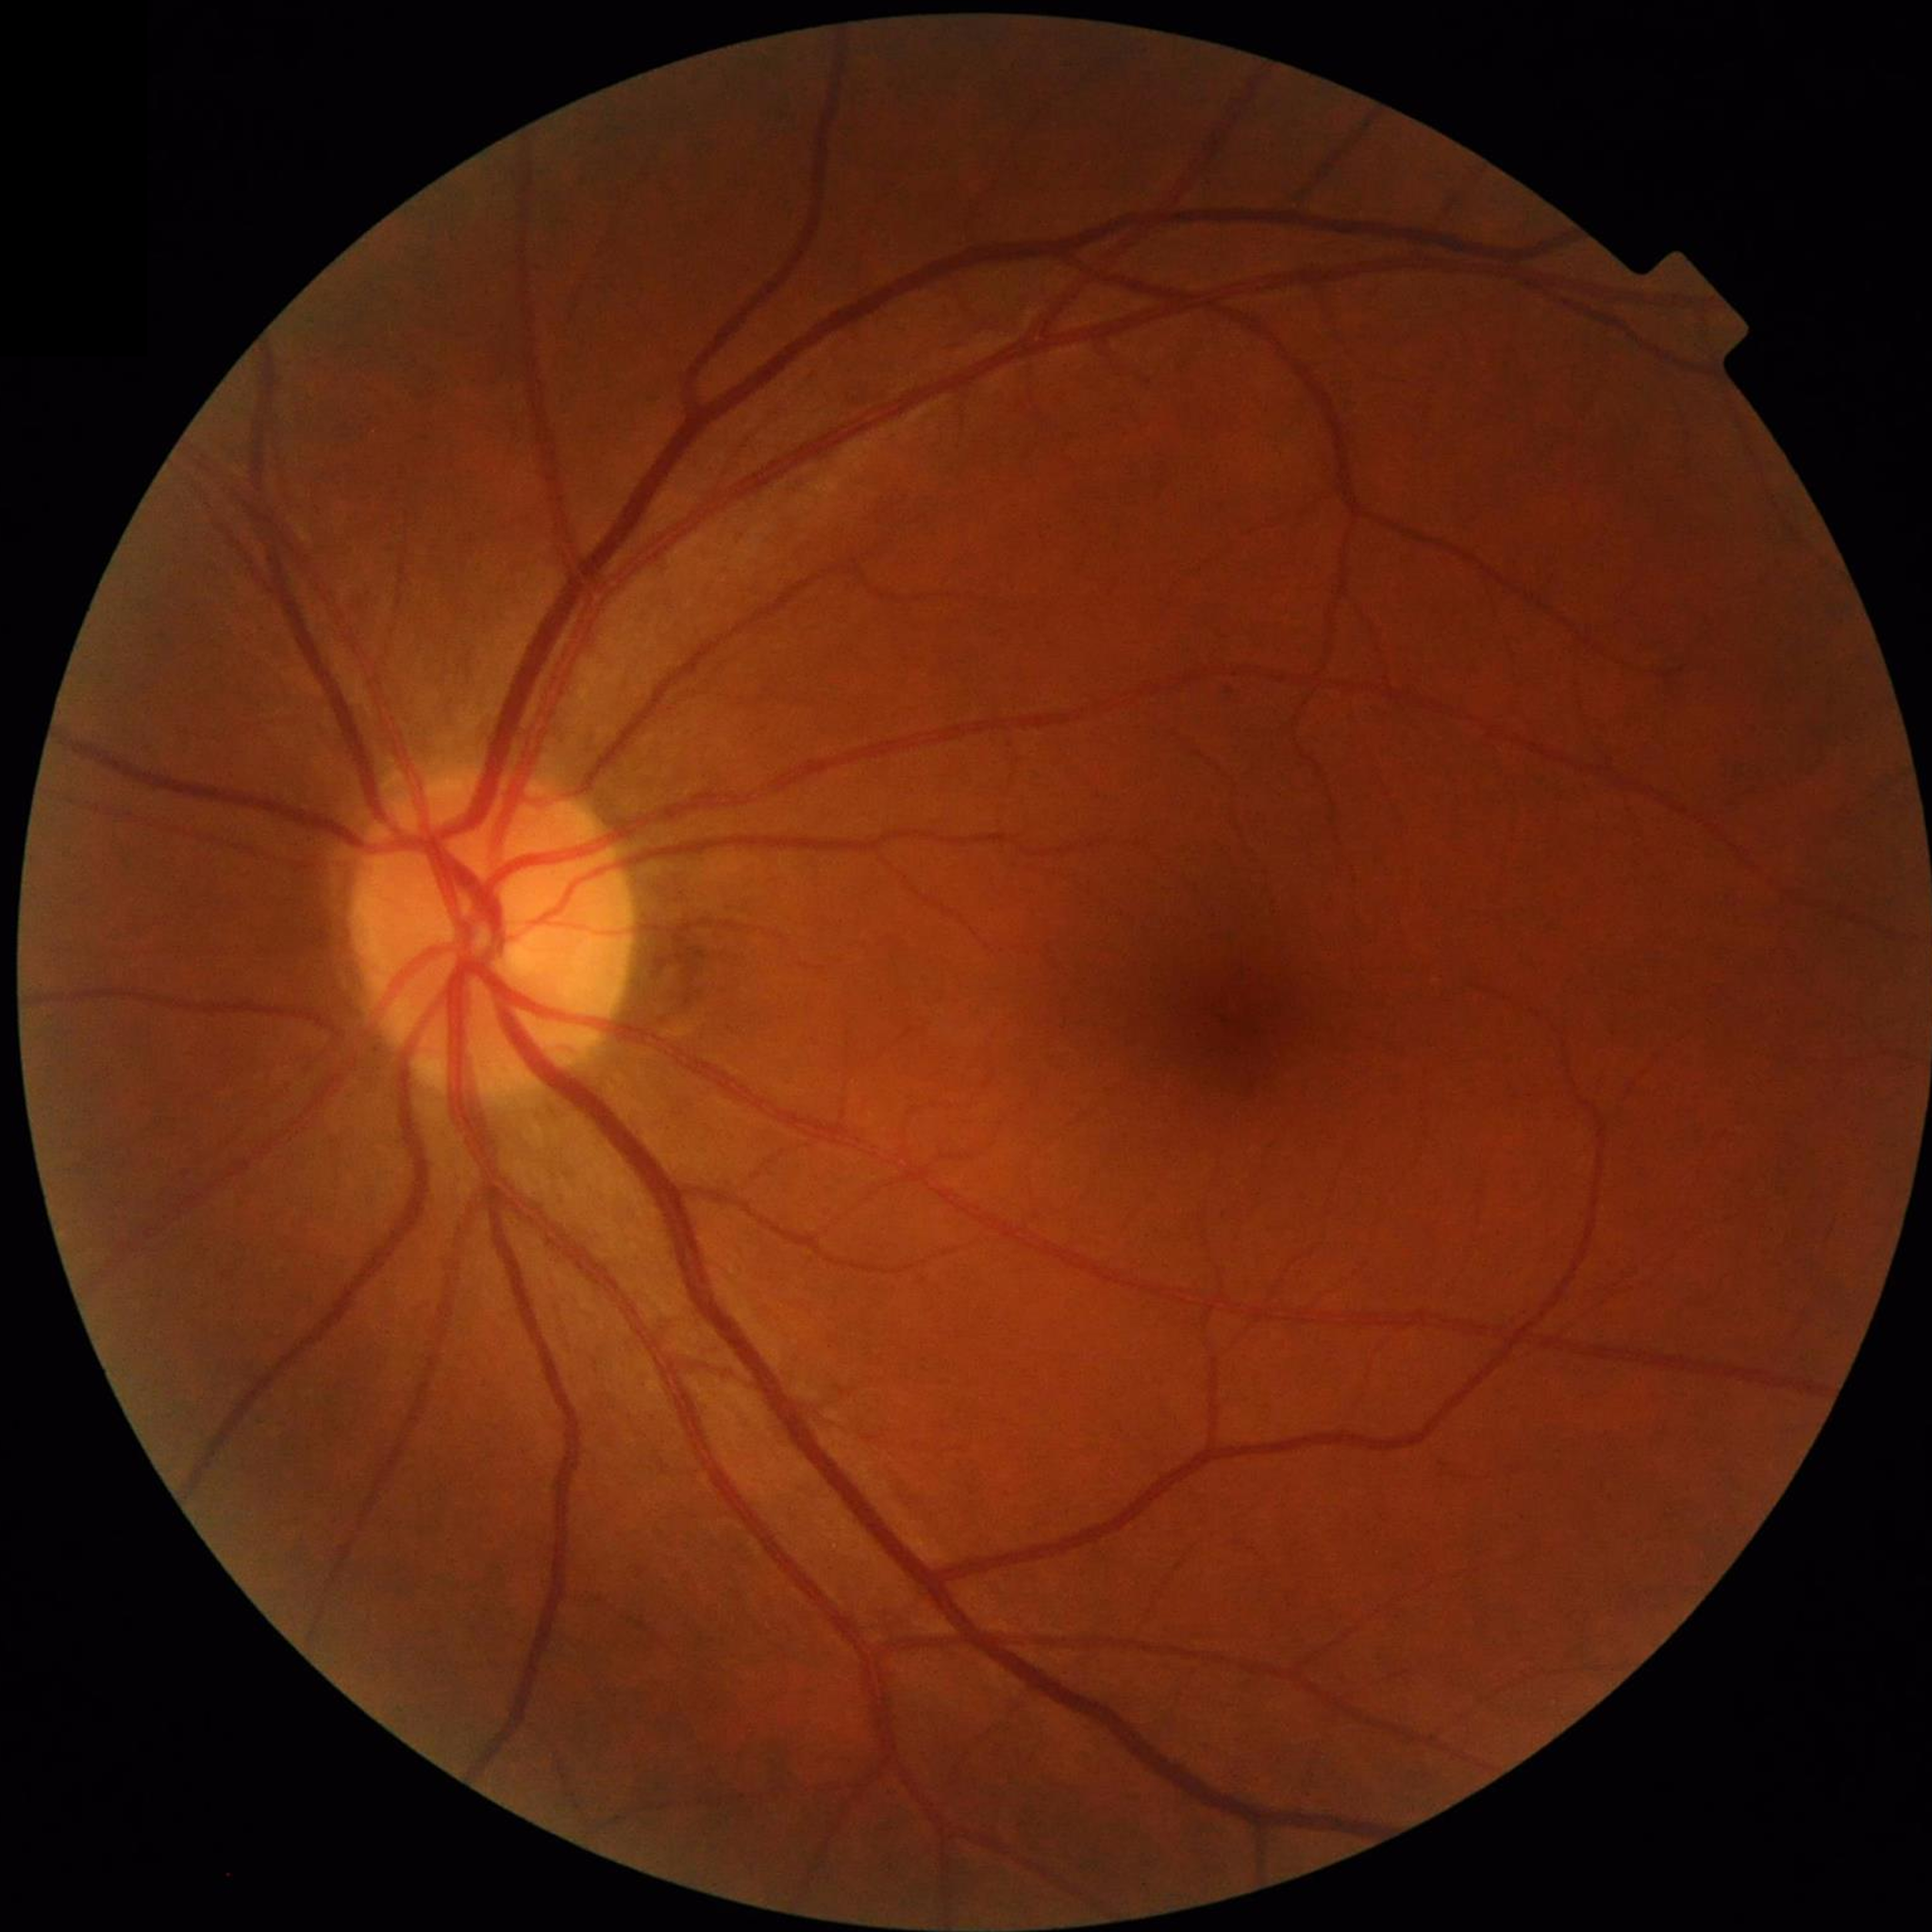
Automated quality assessment: good
Condition: no AMD, diabetic retinopathy, or glaucoma